CFP:
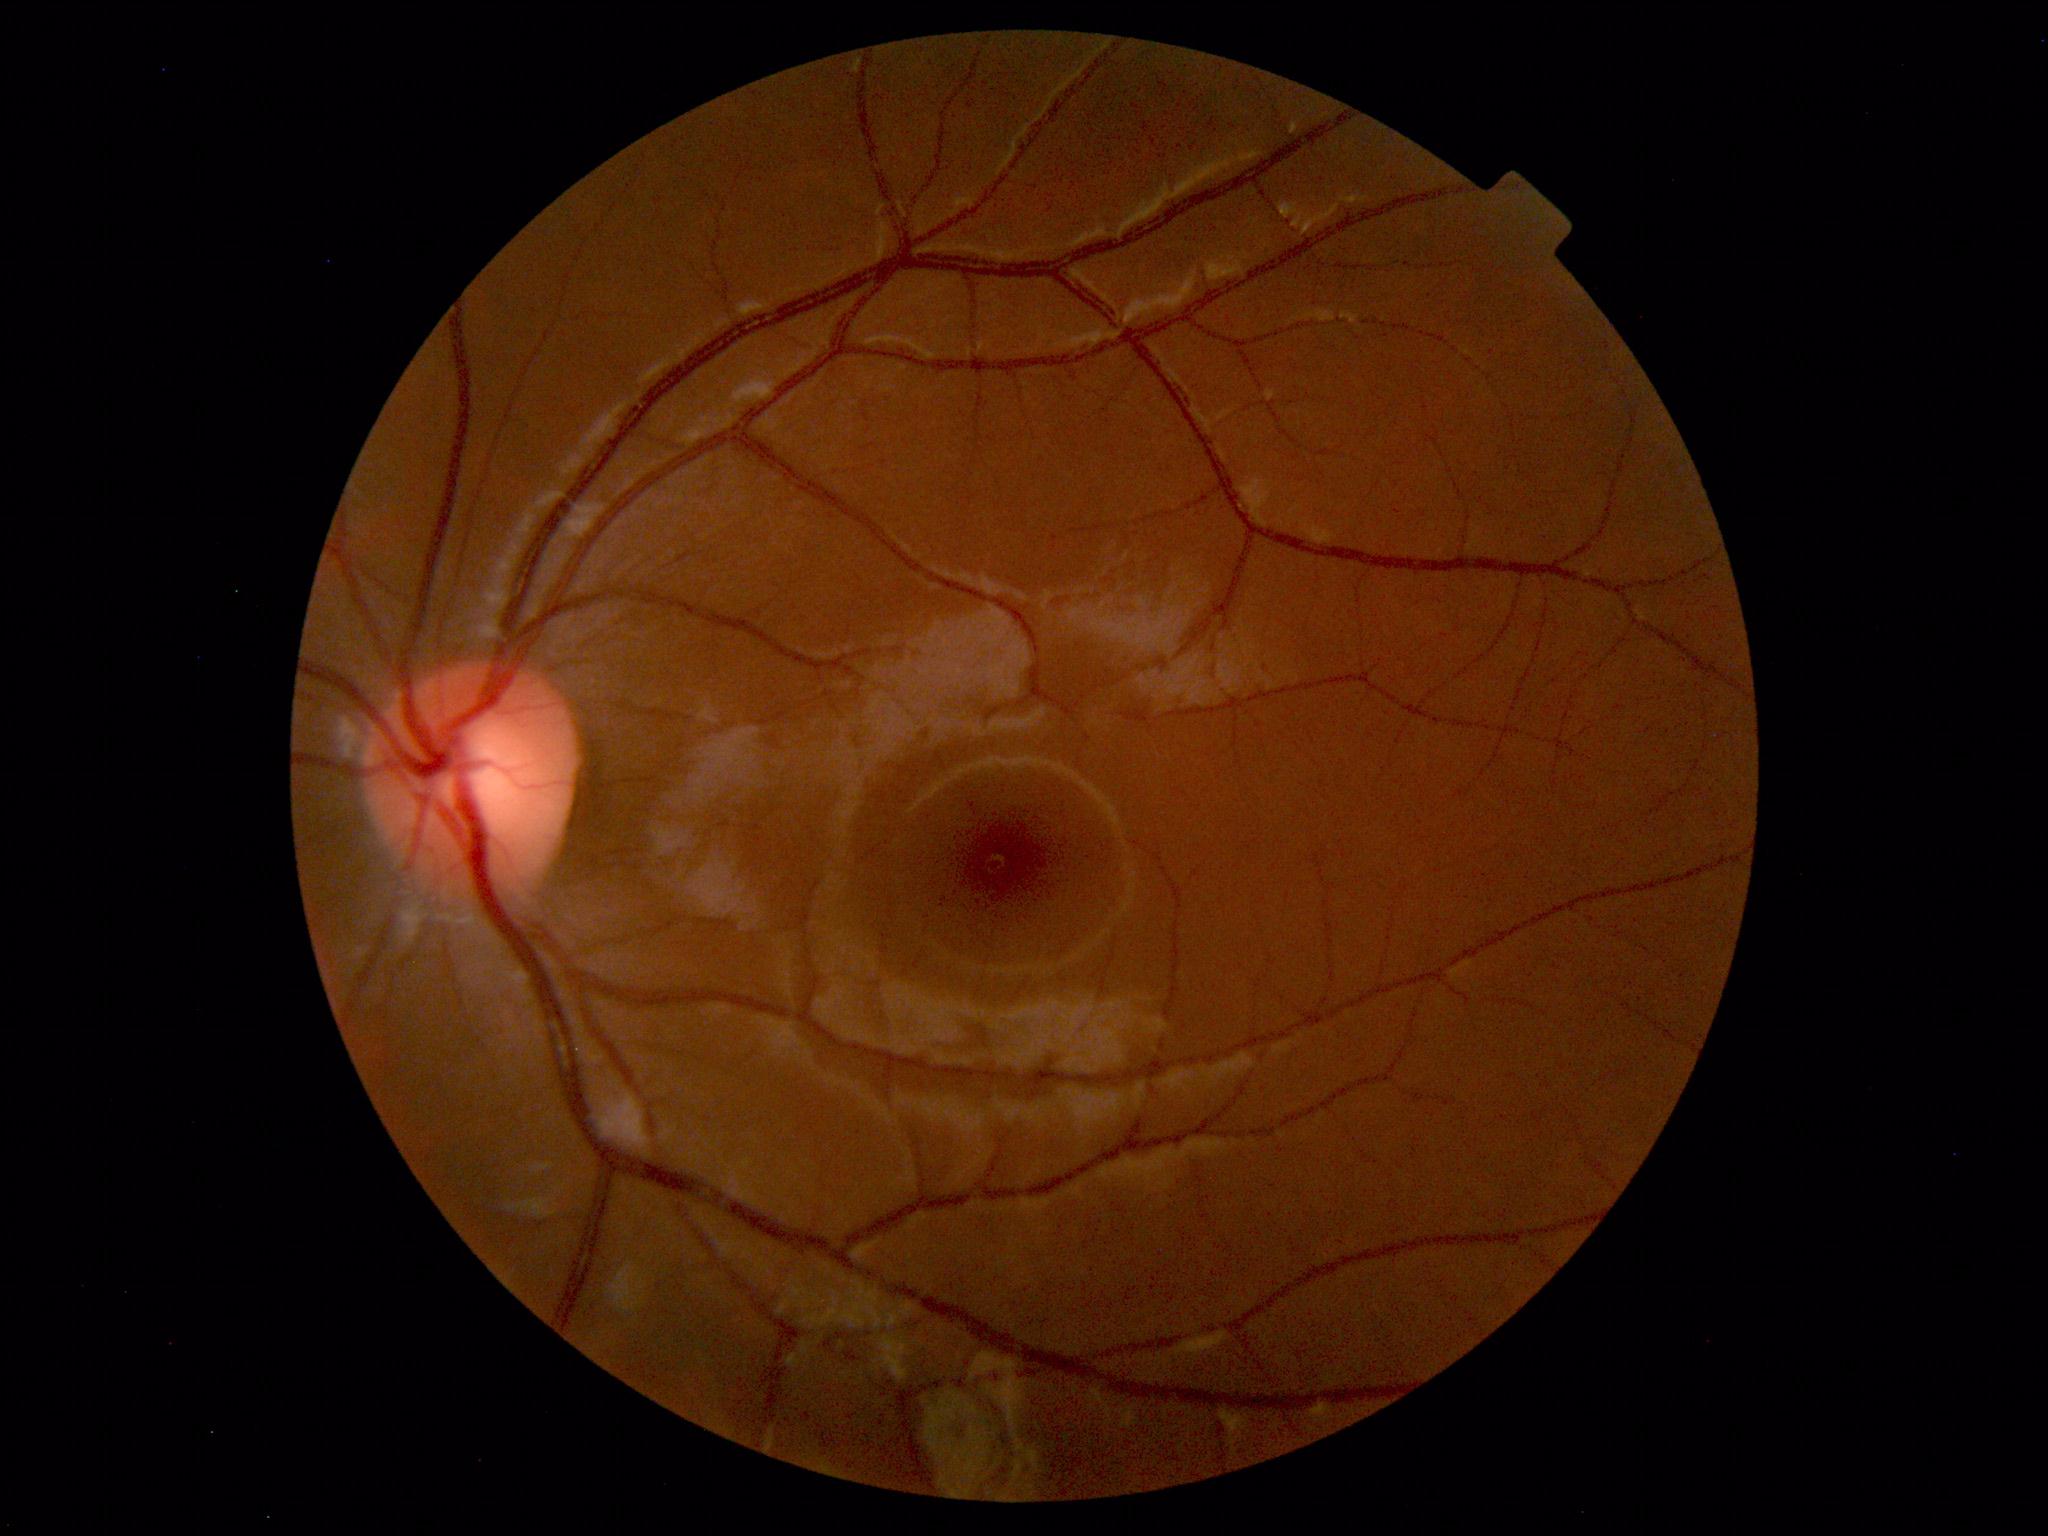
Findings: none. Normal fundus.